Fundus photo. 512x512px
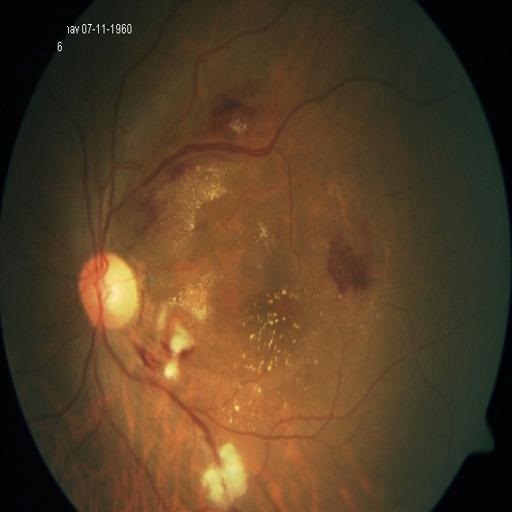 The image shows exudation & retinitis.